Davis DR grading:
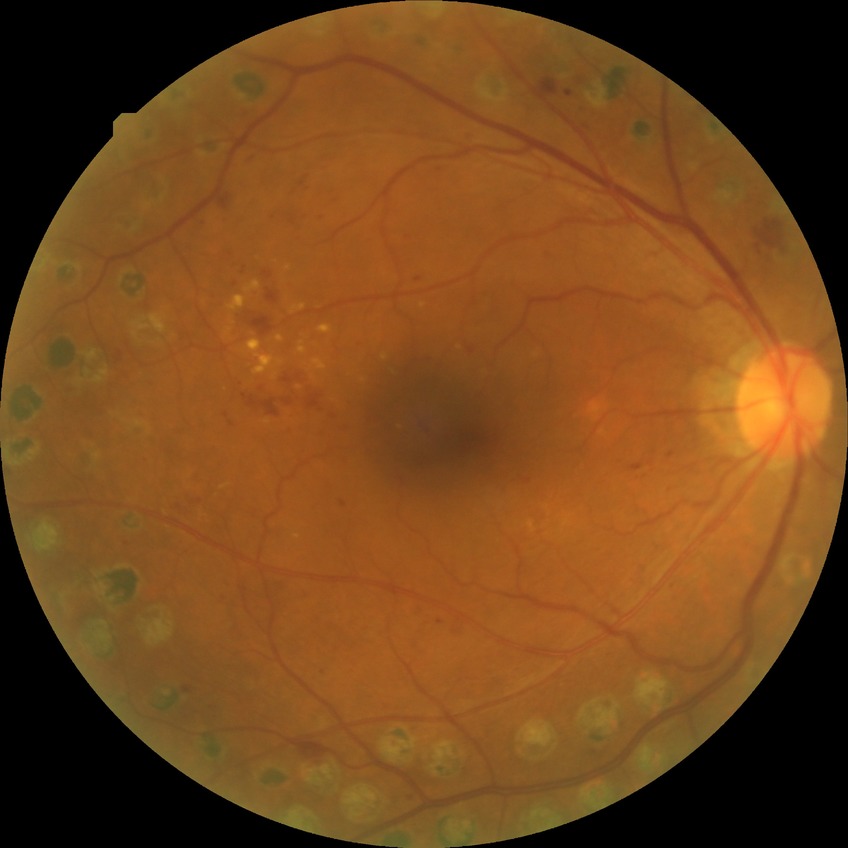

DR is PDR.